Diabetic retinopathy graded by the modified Davis classification:
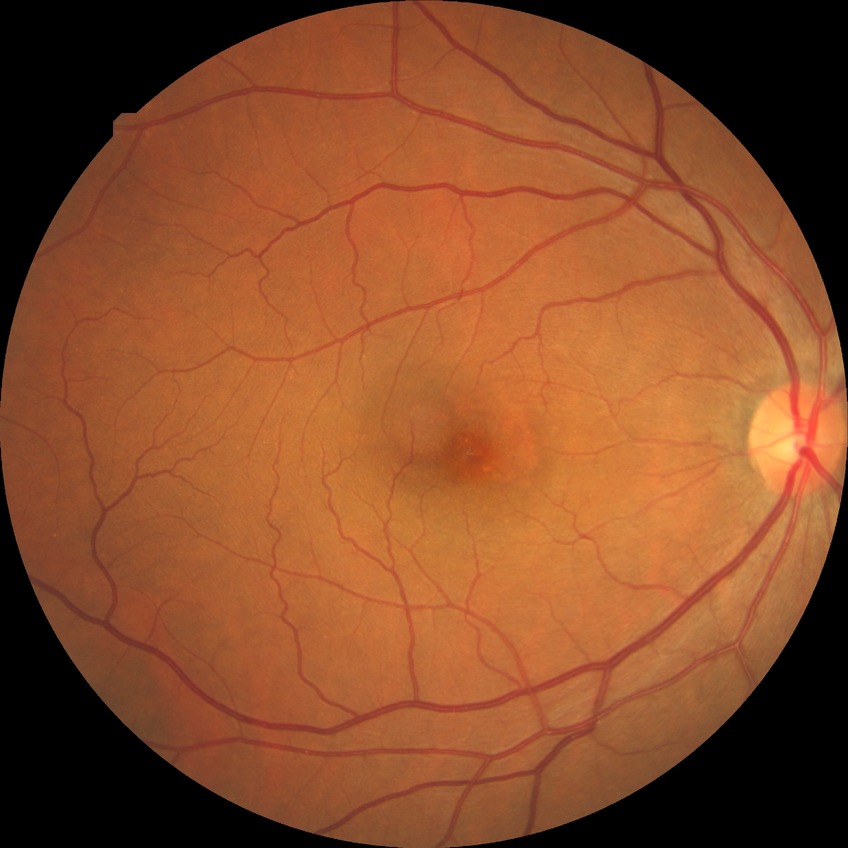

Diabetic retinopathy (DR) is NDR (no diabetic retinopathy).